Color fundus image, Topcon TRC-NW8, centered on the macula
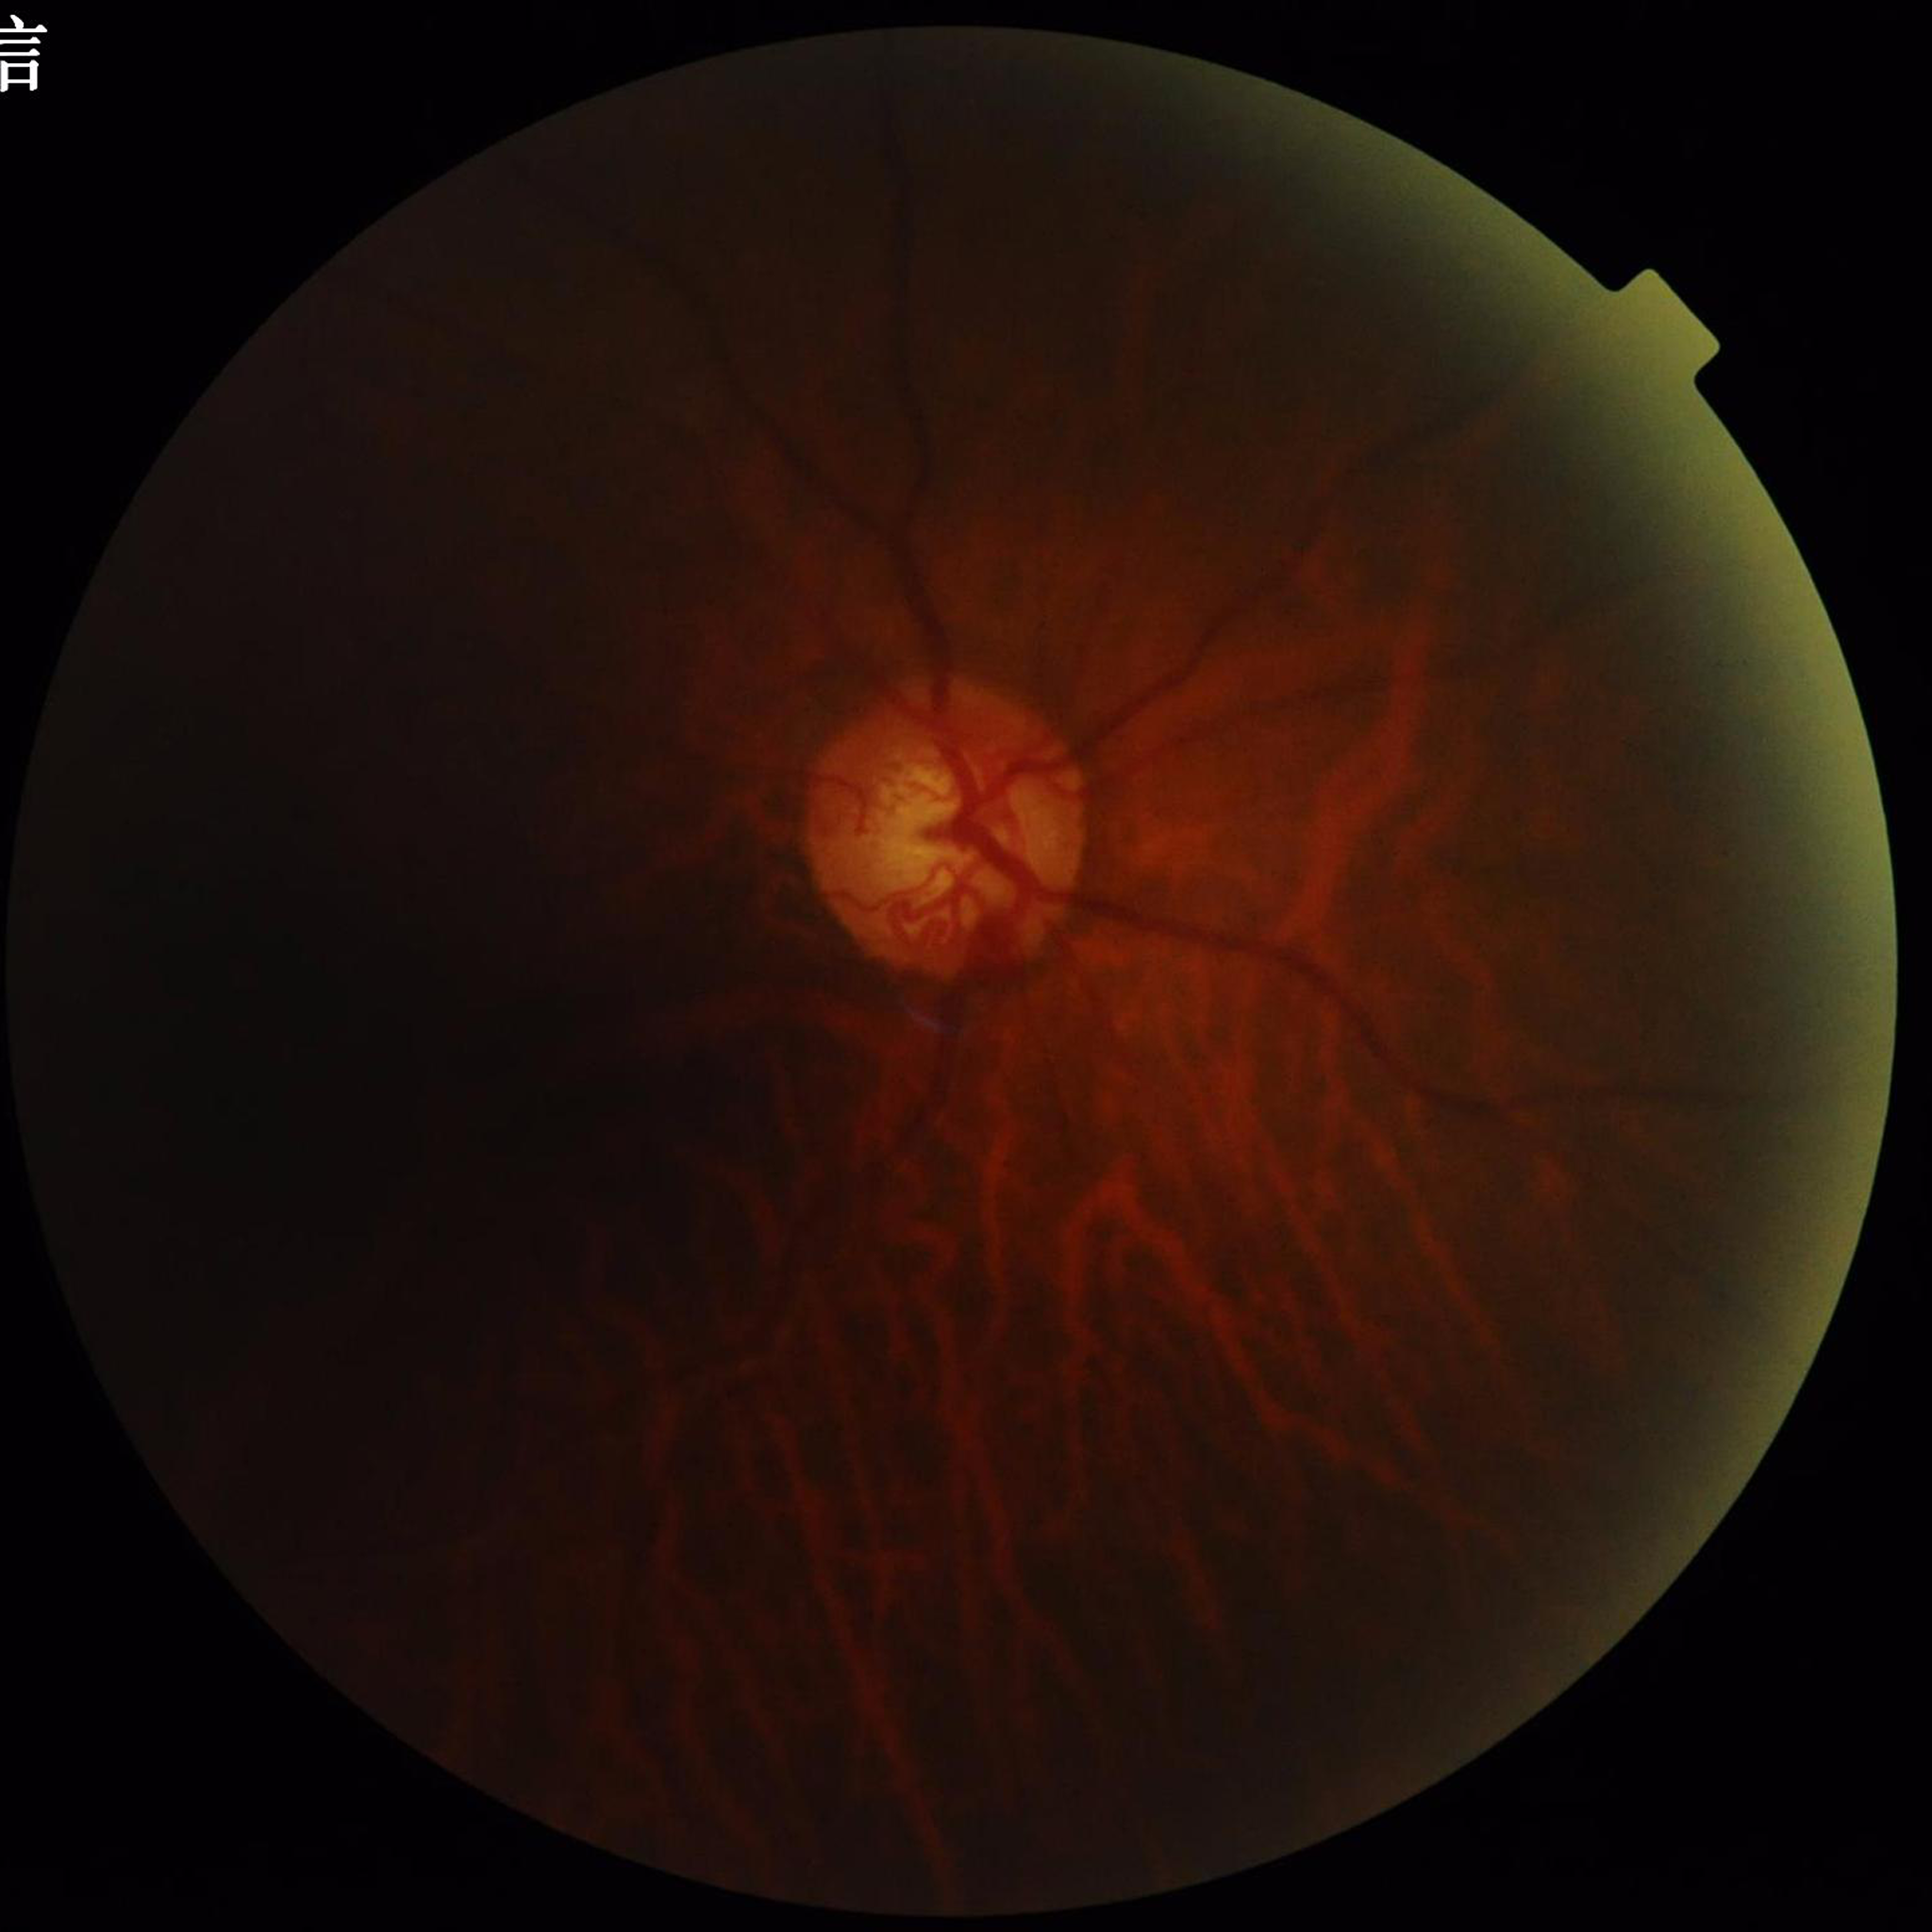

Eye affected by glaucoma.